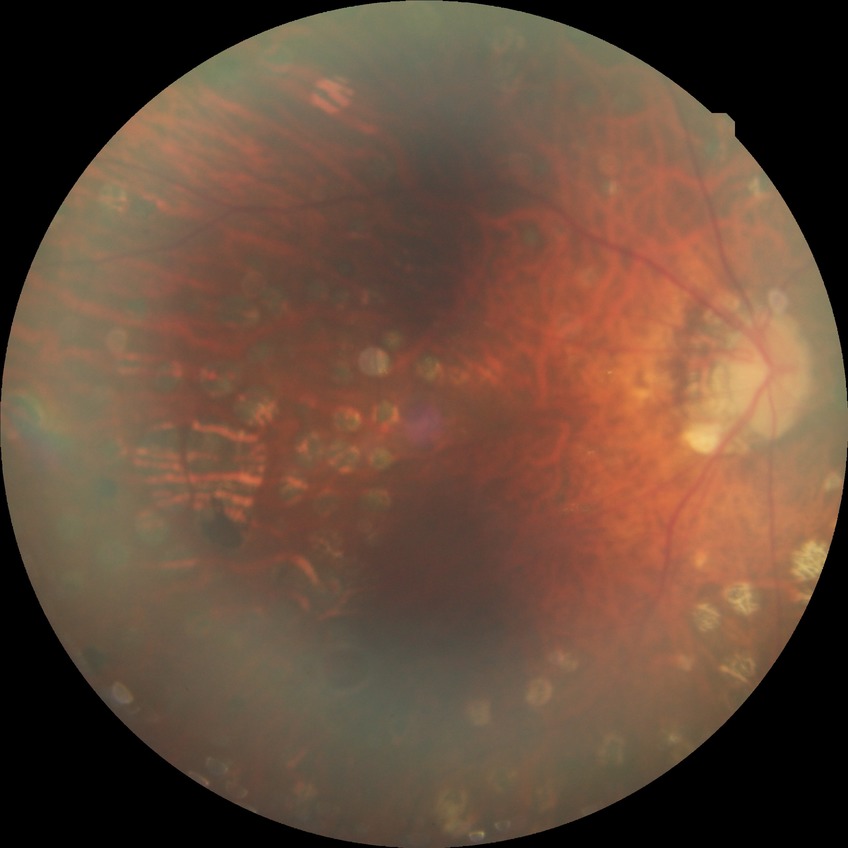
Davis grading: proliferative diabetic retinopathy.